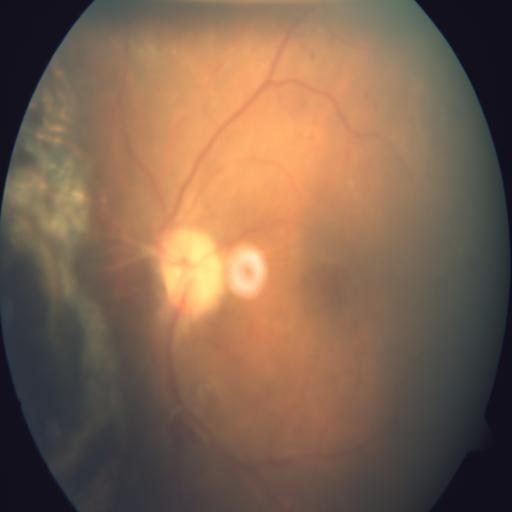
Demonstrates ODP (optic disc pallor) & CRS (chorioretinitis).